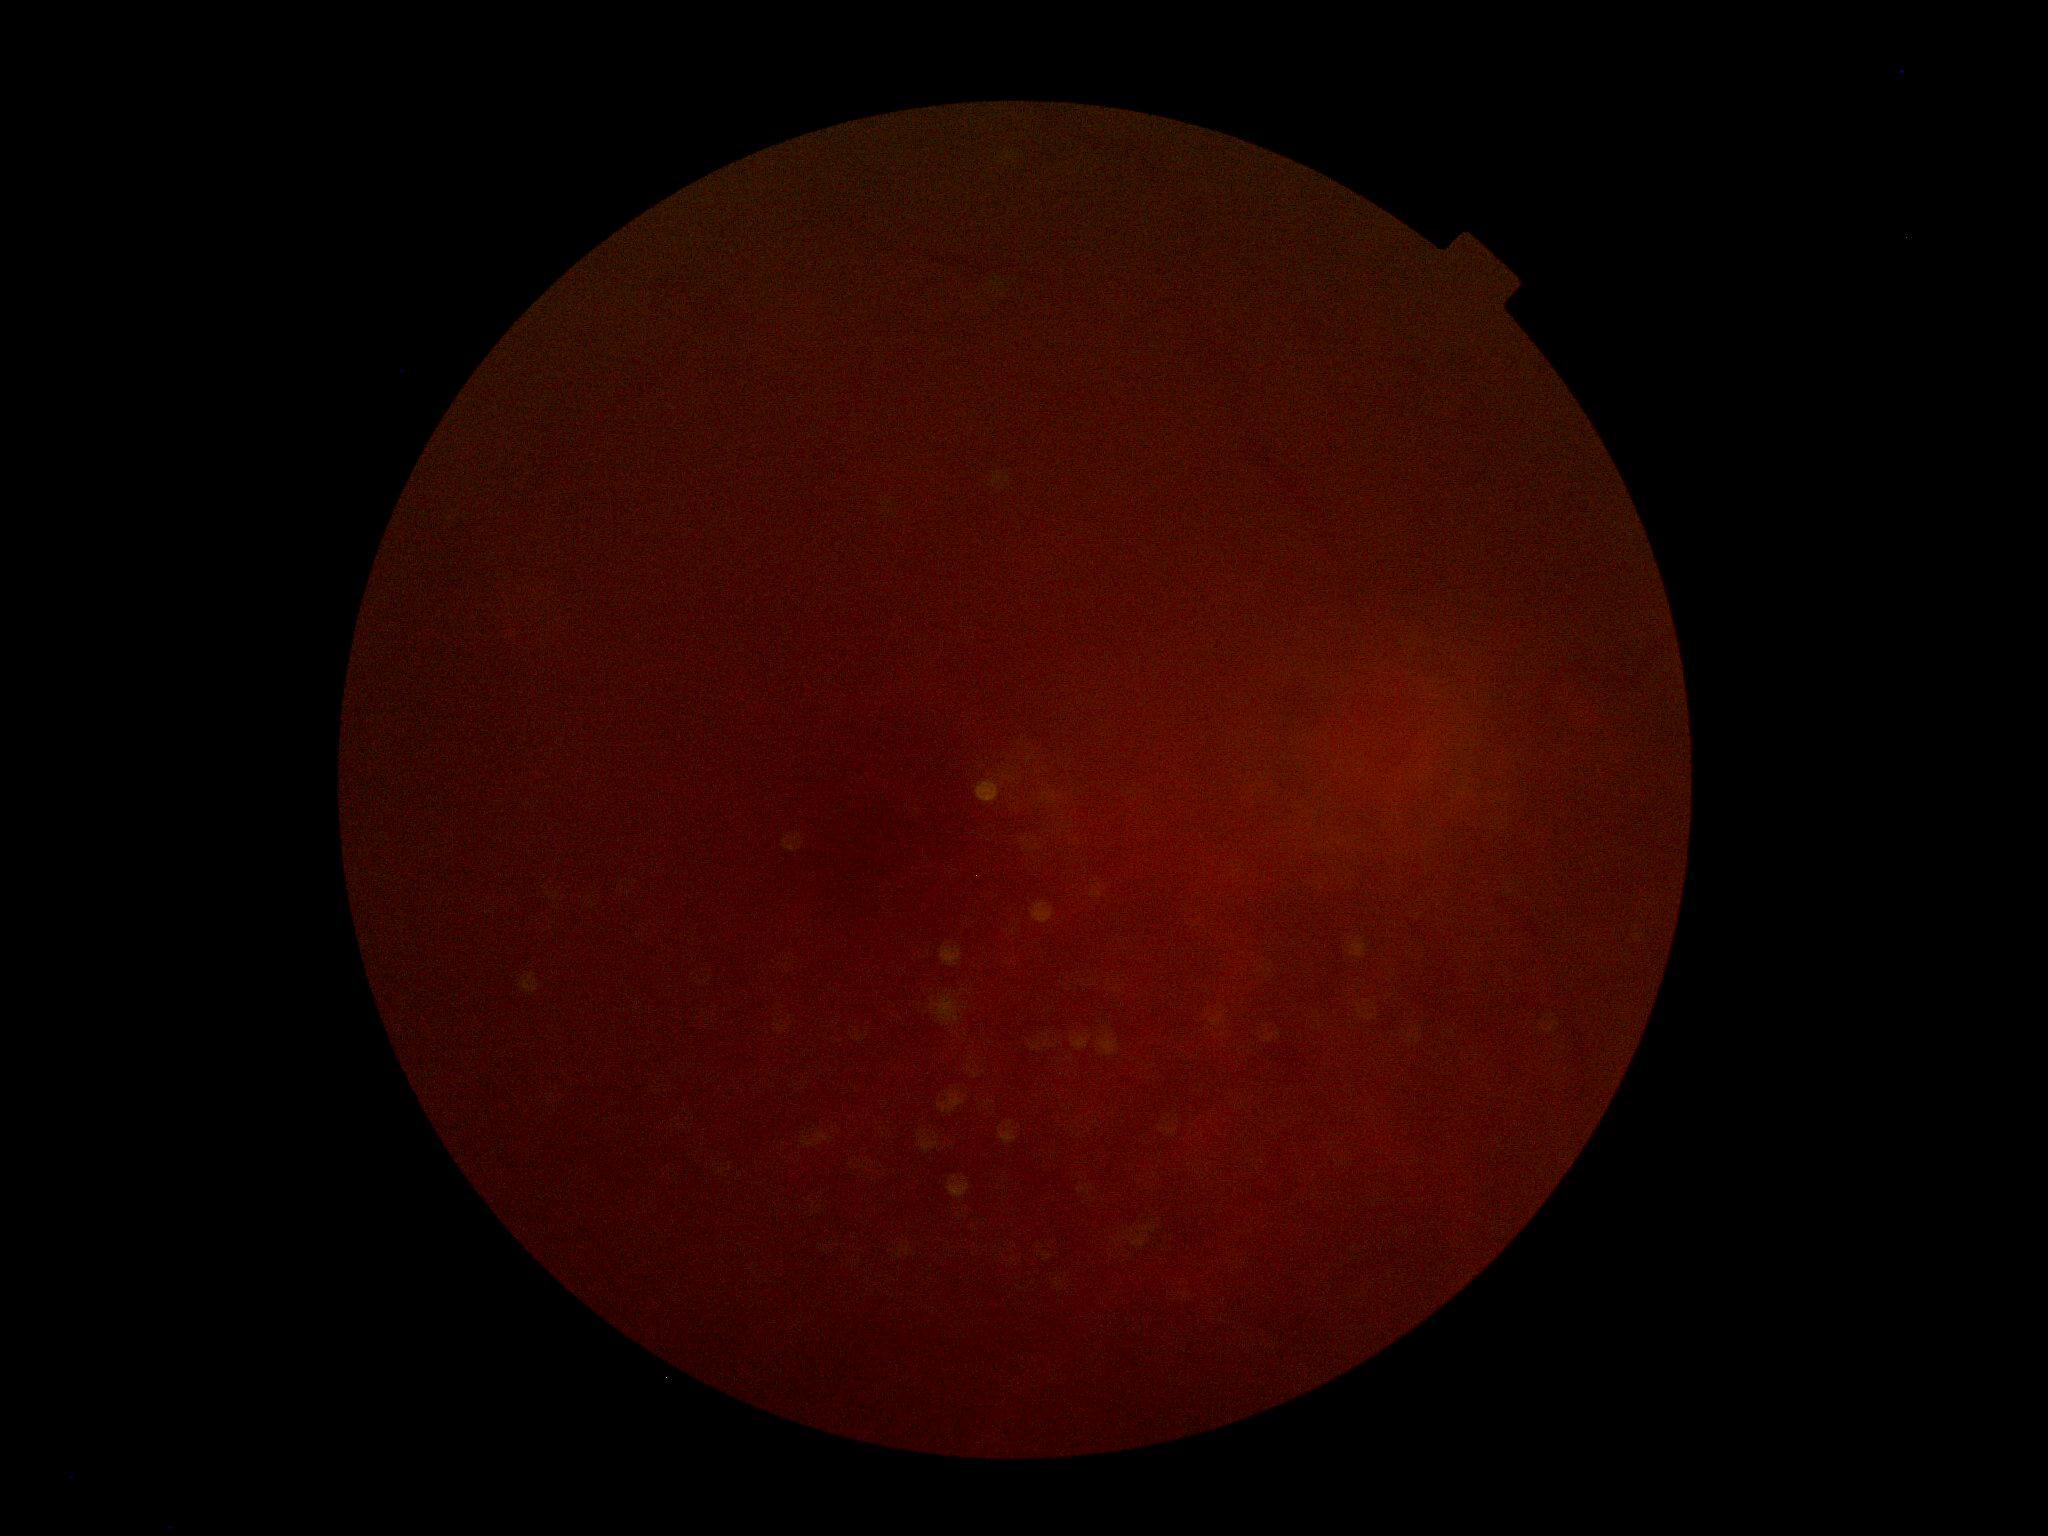
DR stage is ungradable due to poor image quality.